2212x1659: 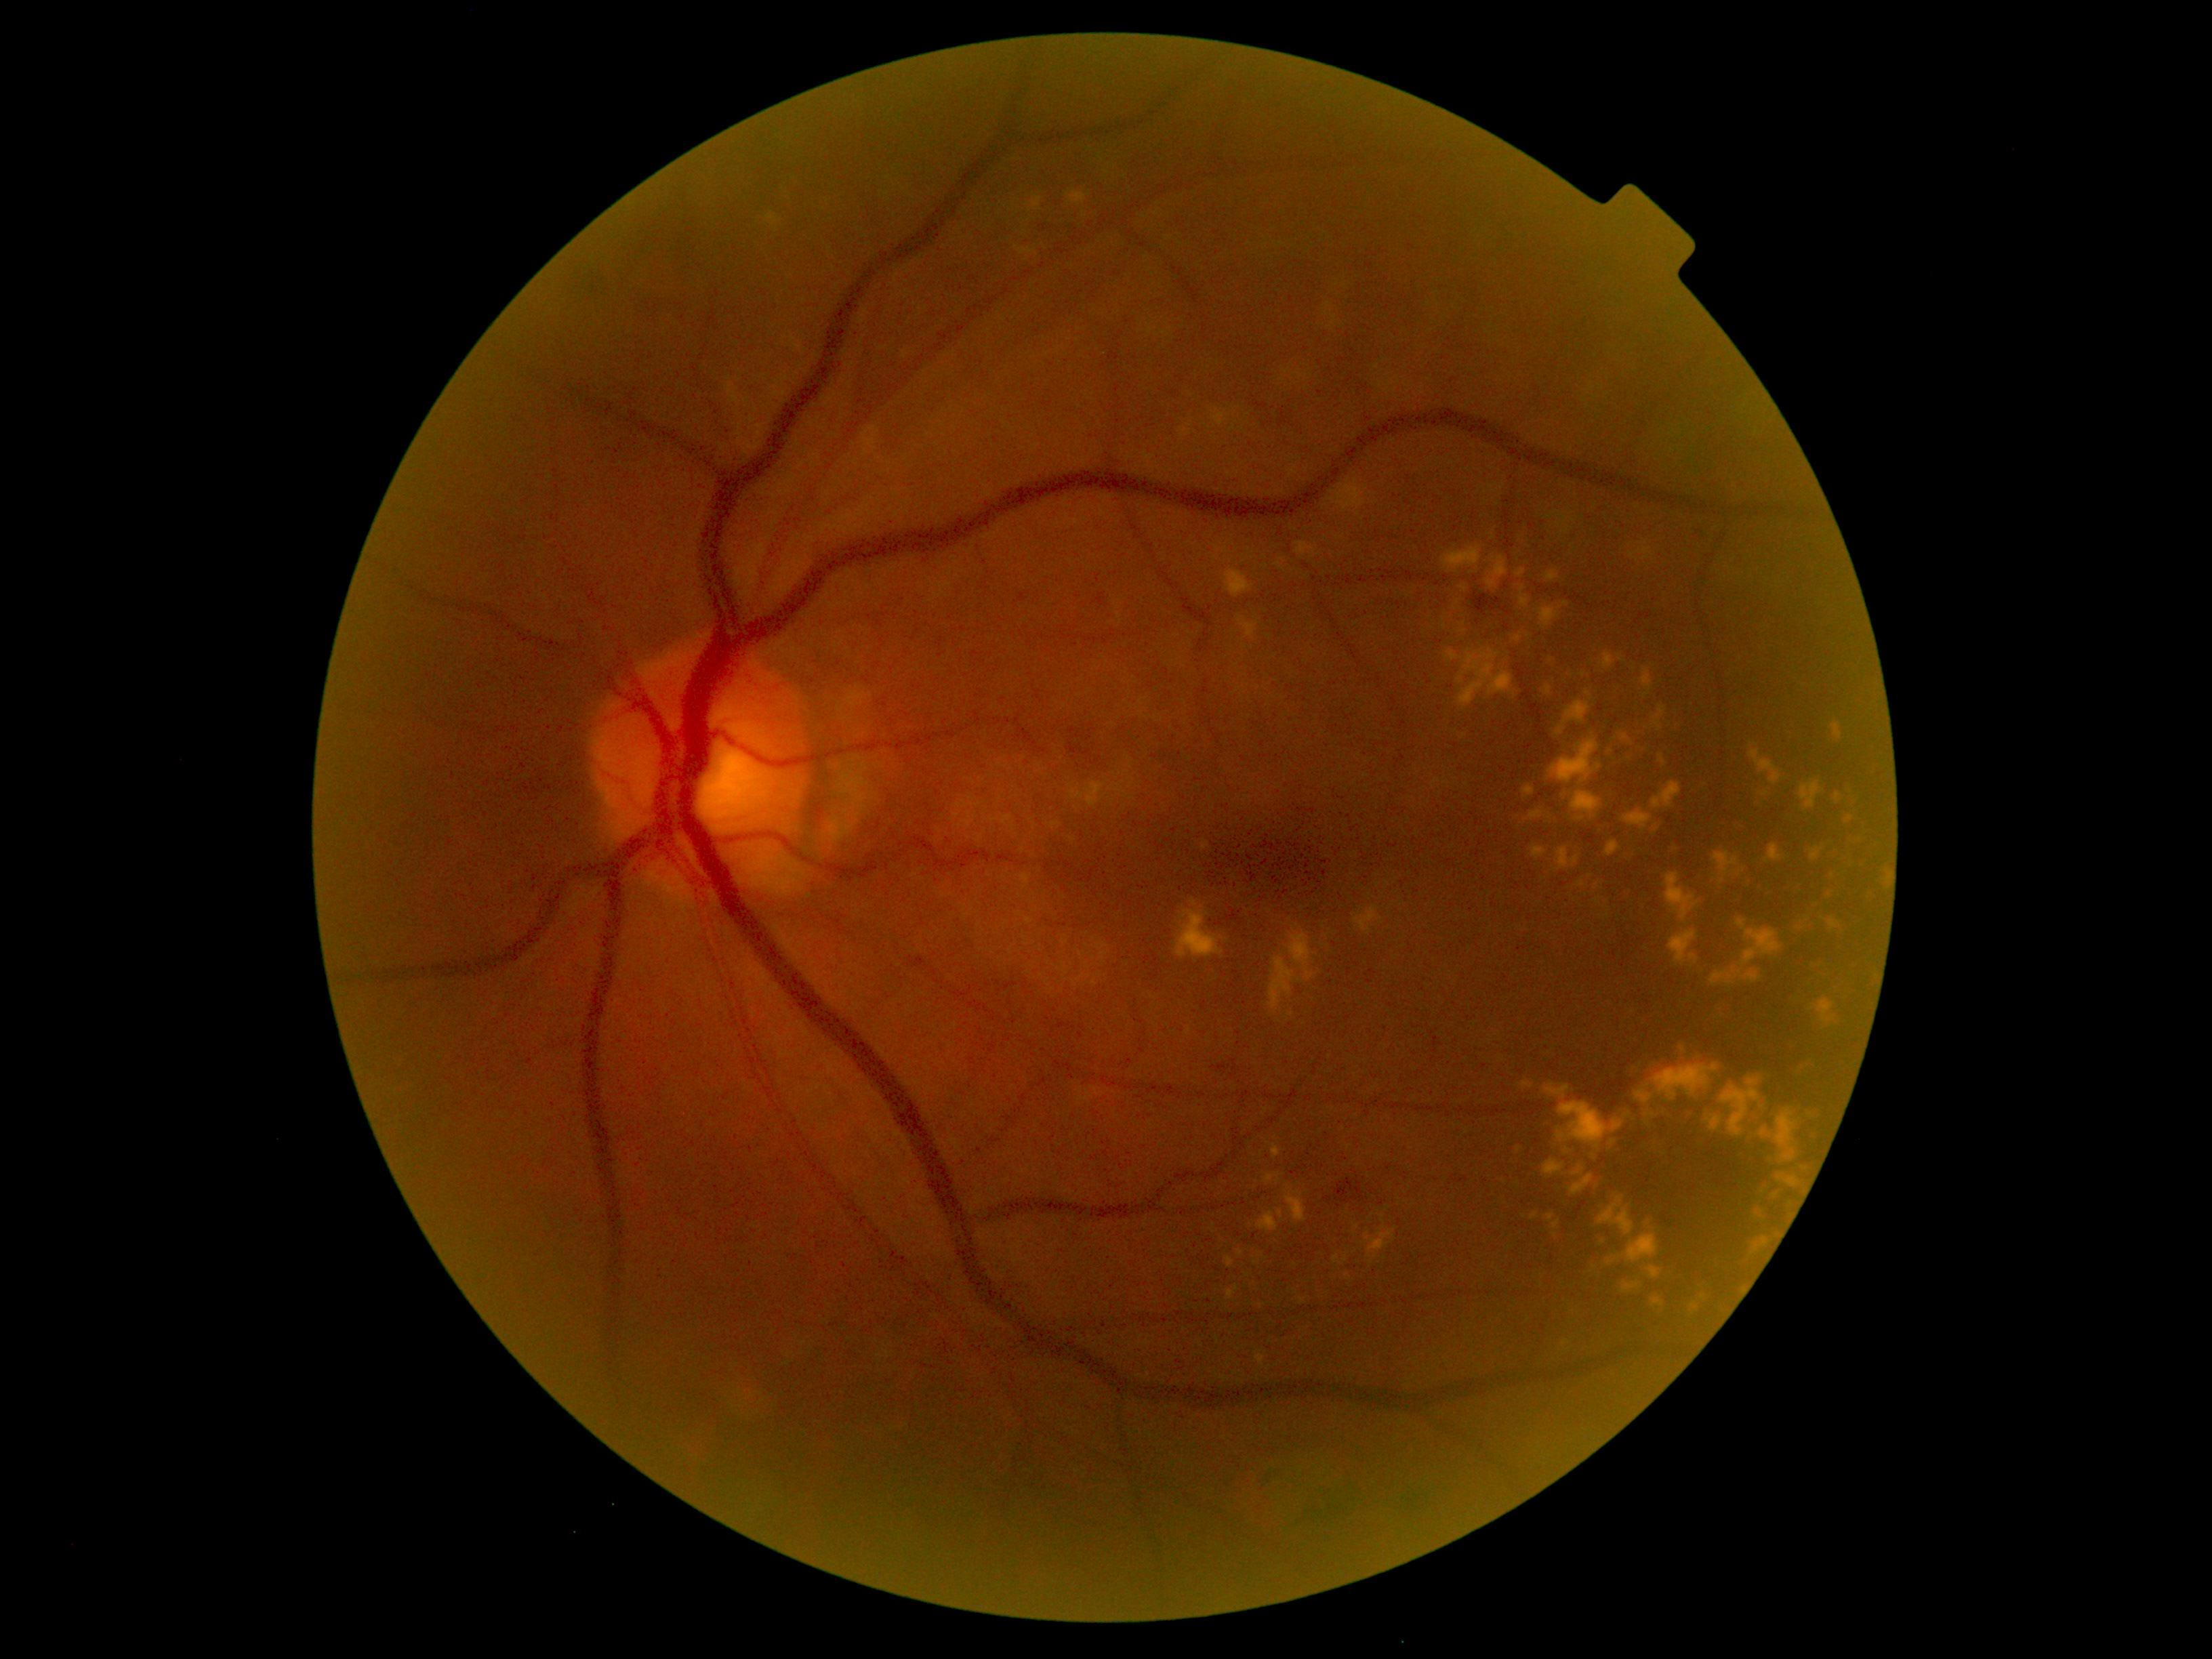

Diabetic retinopathy (DR) is 2/4
Lesions identified (partial list):
soft exudates (SEs): absent
microaneurysms (MAs): absent
hemorrhages (HEs): {"x1": 1040, "y1": 226, "x2": 1048, "y2": 232}, {"x1": 1689, "y1": 520, "x2": 1711, "y2": 540}, {"x1": 1063, "y1": 224, "x2": 1074, "y2": 237}, {"x1": 1334, "y1": 1179, "x2": 1367, "y2": 1203}, {"x1": 1212, "y1": 1063, "x2": 1229, "y2": 1073}, {"x1": 1366, "y1": 262, "x2": 1374, "y2": 269}, {"x1": 663, "y1": 212, "x2": 700, "y2": 264}, {"x1": 636, "y1": 289, "x2": 699, "y2": 321}, {"x1": 1325, "y1": 1196, "x2": 1333, "y2": 1203}, {"x1": 1470, "y1": 593, "x2": 1502, "y2": 617}, {"x1": 920, "y1": 173, "x2": 947, "y2": 193}, {"x1": 577, "y1": 262, "x2": 613, "y2": 306}
Small HEs approximately at {"x": 1667, "y": 1220}
hard exudates (EXs) (more not shown): {"x1": 1624, "y1": 844, "x2": 1642, "y2": 863}, {"x1": 1817, "y1": 1000, "x2": 1836, "y2": 1023}, {"x1": 1750, "y1": 788, "x2": 1776, "y2": 817}, {"x1": 1668, "y1": 929, "x2": 1699, "y2": 966}, {"x1": 1268, "y1": 1142, "x2": 1282, "y2": 1160}, {"x1": 1223, "y1": 569, "x2": 1254, "y2": 598}, {"x1": 1517, "y1": 1063, "x2": 1822, "y2": 1314}, {"x1": 1833, "y1": 722, "x2": 1843, "y2": 739}, {"x1": 1544, "y1": 685, "x2": 1551, "y2": 696}, {"x1": 1557, "y1": 848, "x2": 1580, "y2": 869}, {"x1": 1736, "y1": 869, "x2": 1746, "y2": 874}, {"x1": 1710, "y1": 991, "x2": 1741, "y2": 1033}, {"x1": 1277, "y1": 1208, "x2": 1284, "y2": 1223}, {"x1": 1523, "y1": 785, "x2": 1535, "y2": 796}, {"x1": 1607, "y1": 716, "x2": 1656, "y2": 772}, {"x1": 1532, "y1": 846, "x2": 1547, "y2": 860}
Small EXs approximately at {"x": 1621, "y": 659}, {"x": 1290, "y": 1015}, {"x": 1302, "y": 1301}, {"x": 1520, "y": 1149}